45-degree field of view: 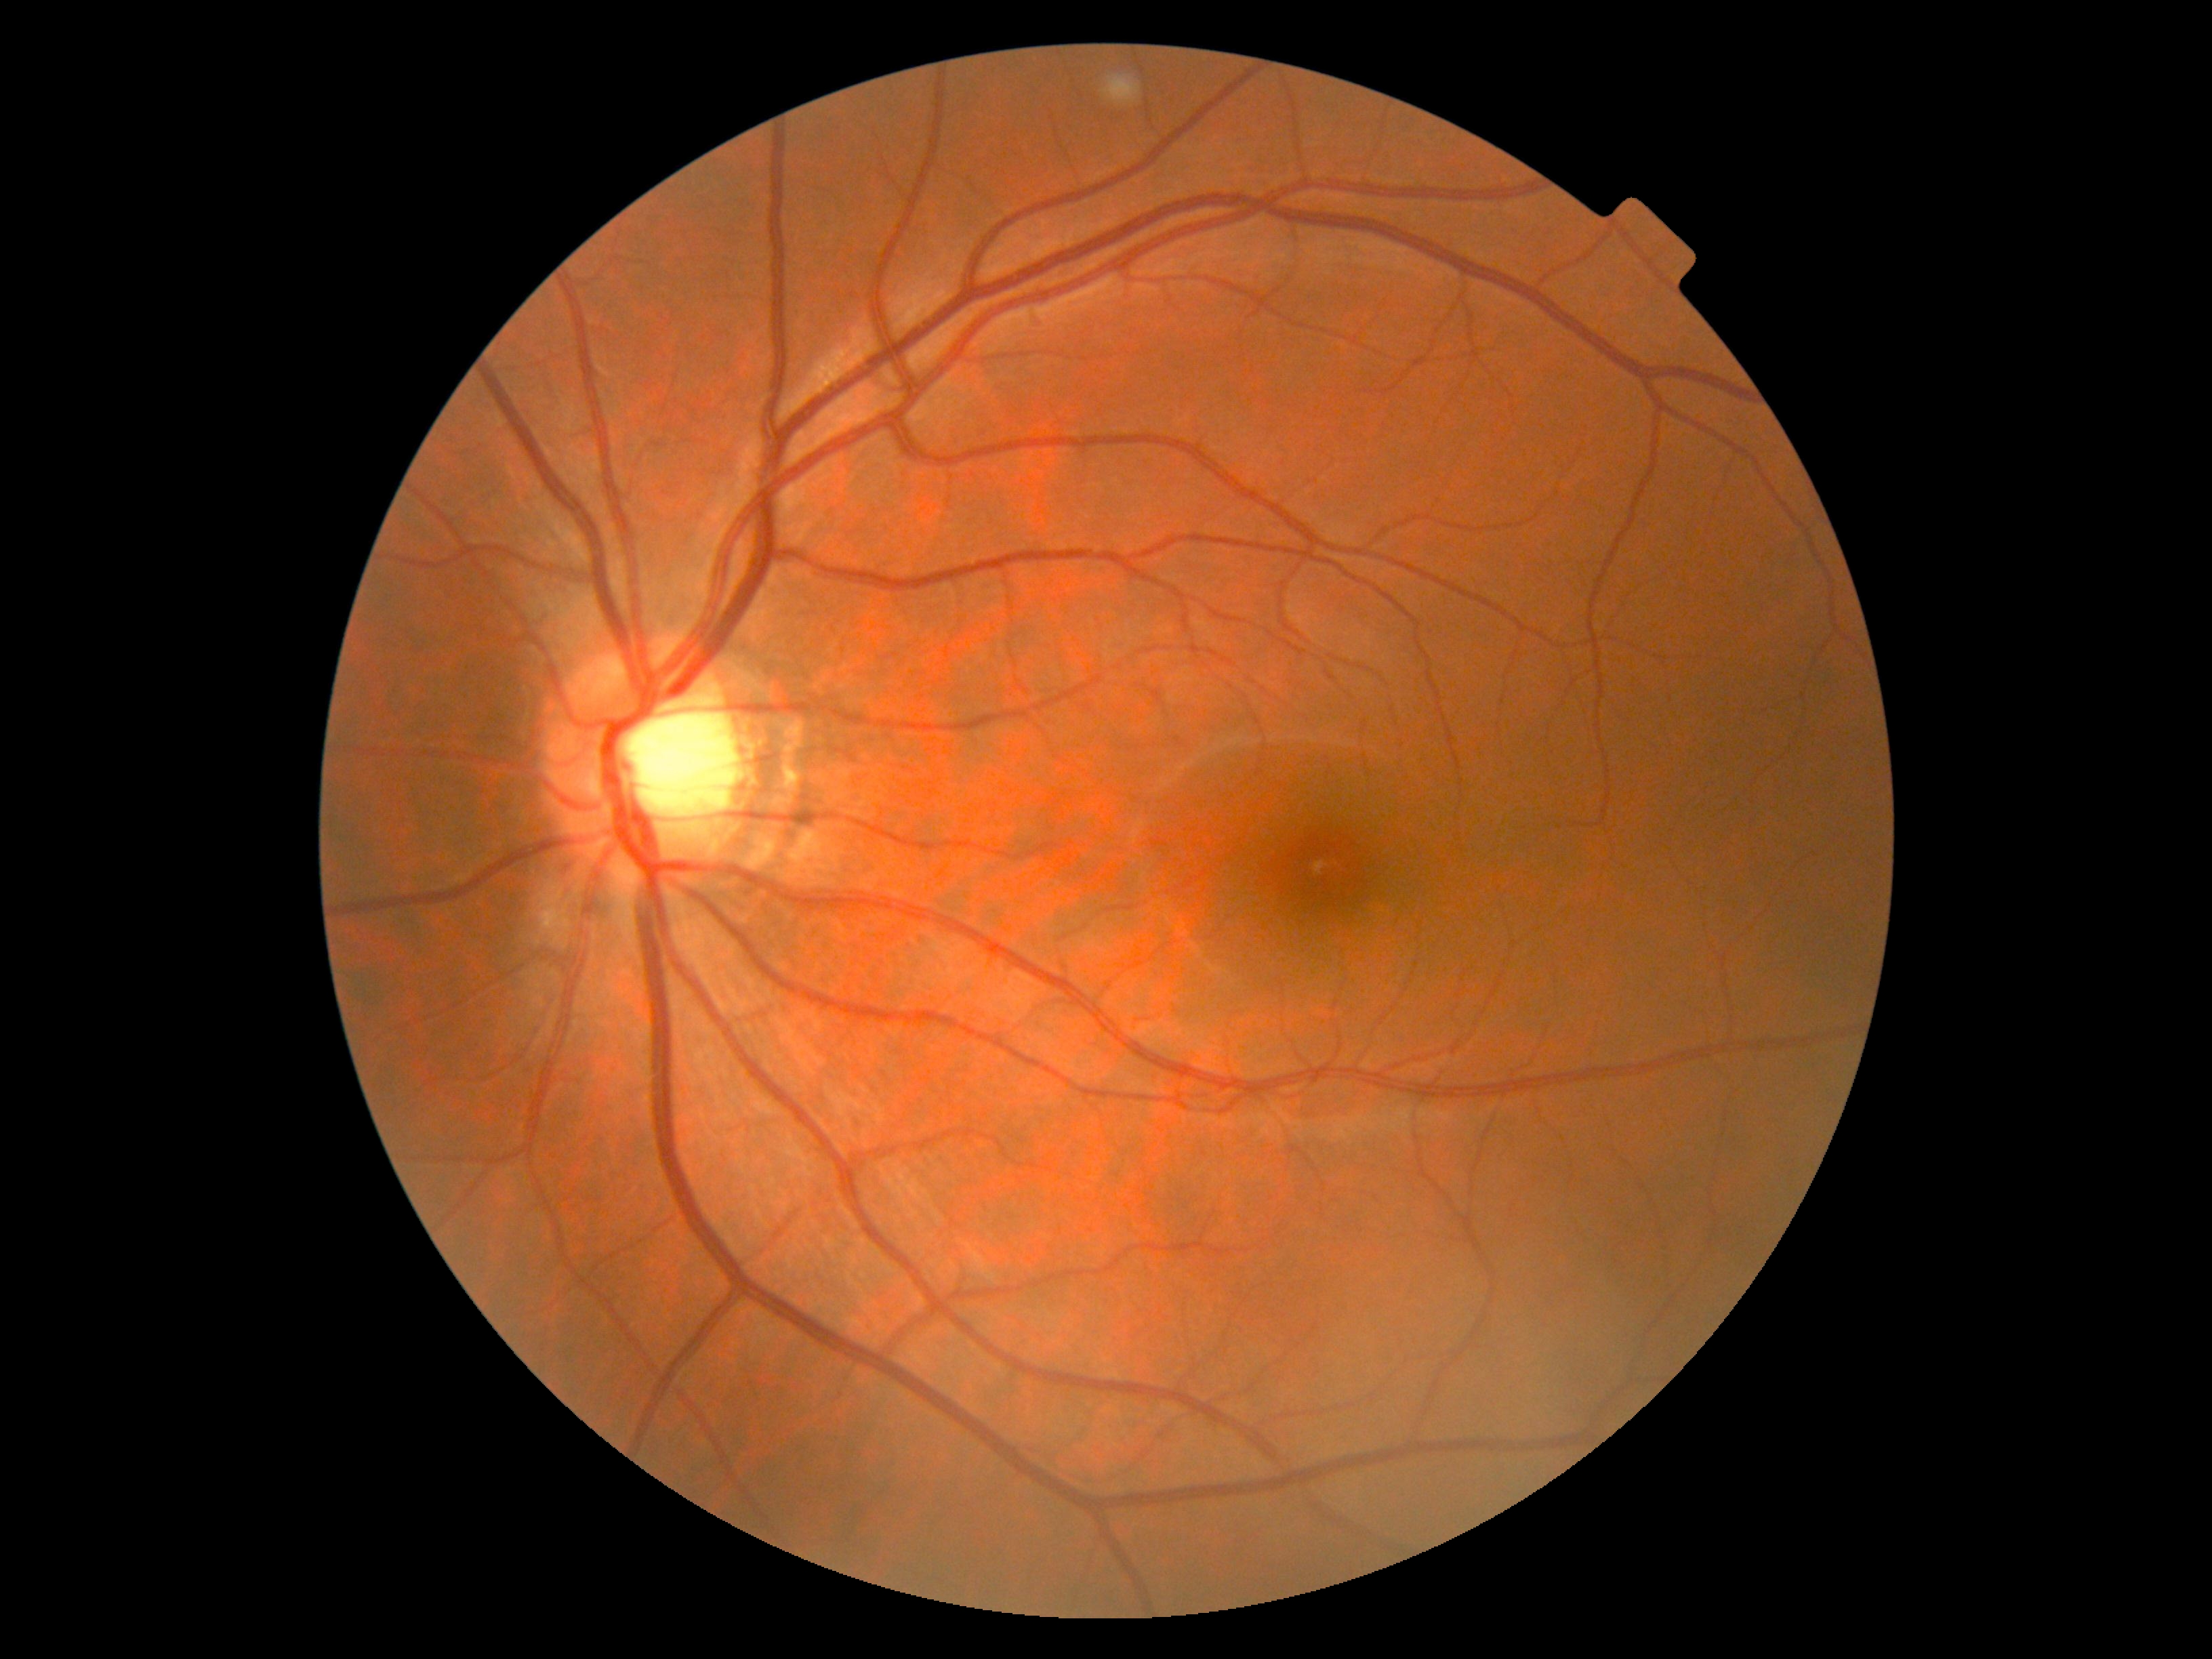
diabetic retinopathy severity: 0/4.